130° field of view (Clarity RetCam 3). 640 by 480 pixels. Wide-field fundus image from infant ROP screening: 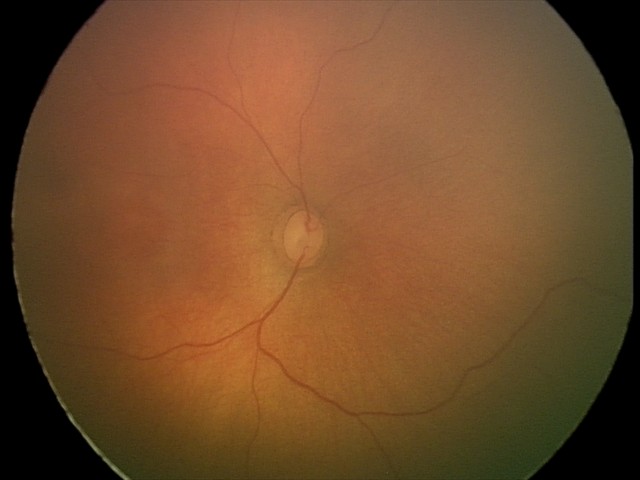

Screening diagnosis: no abnormalities.